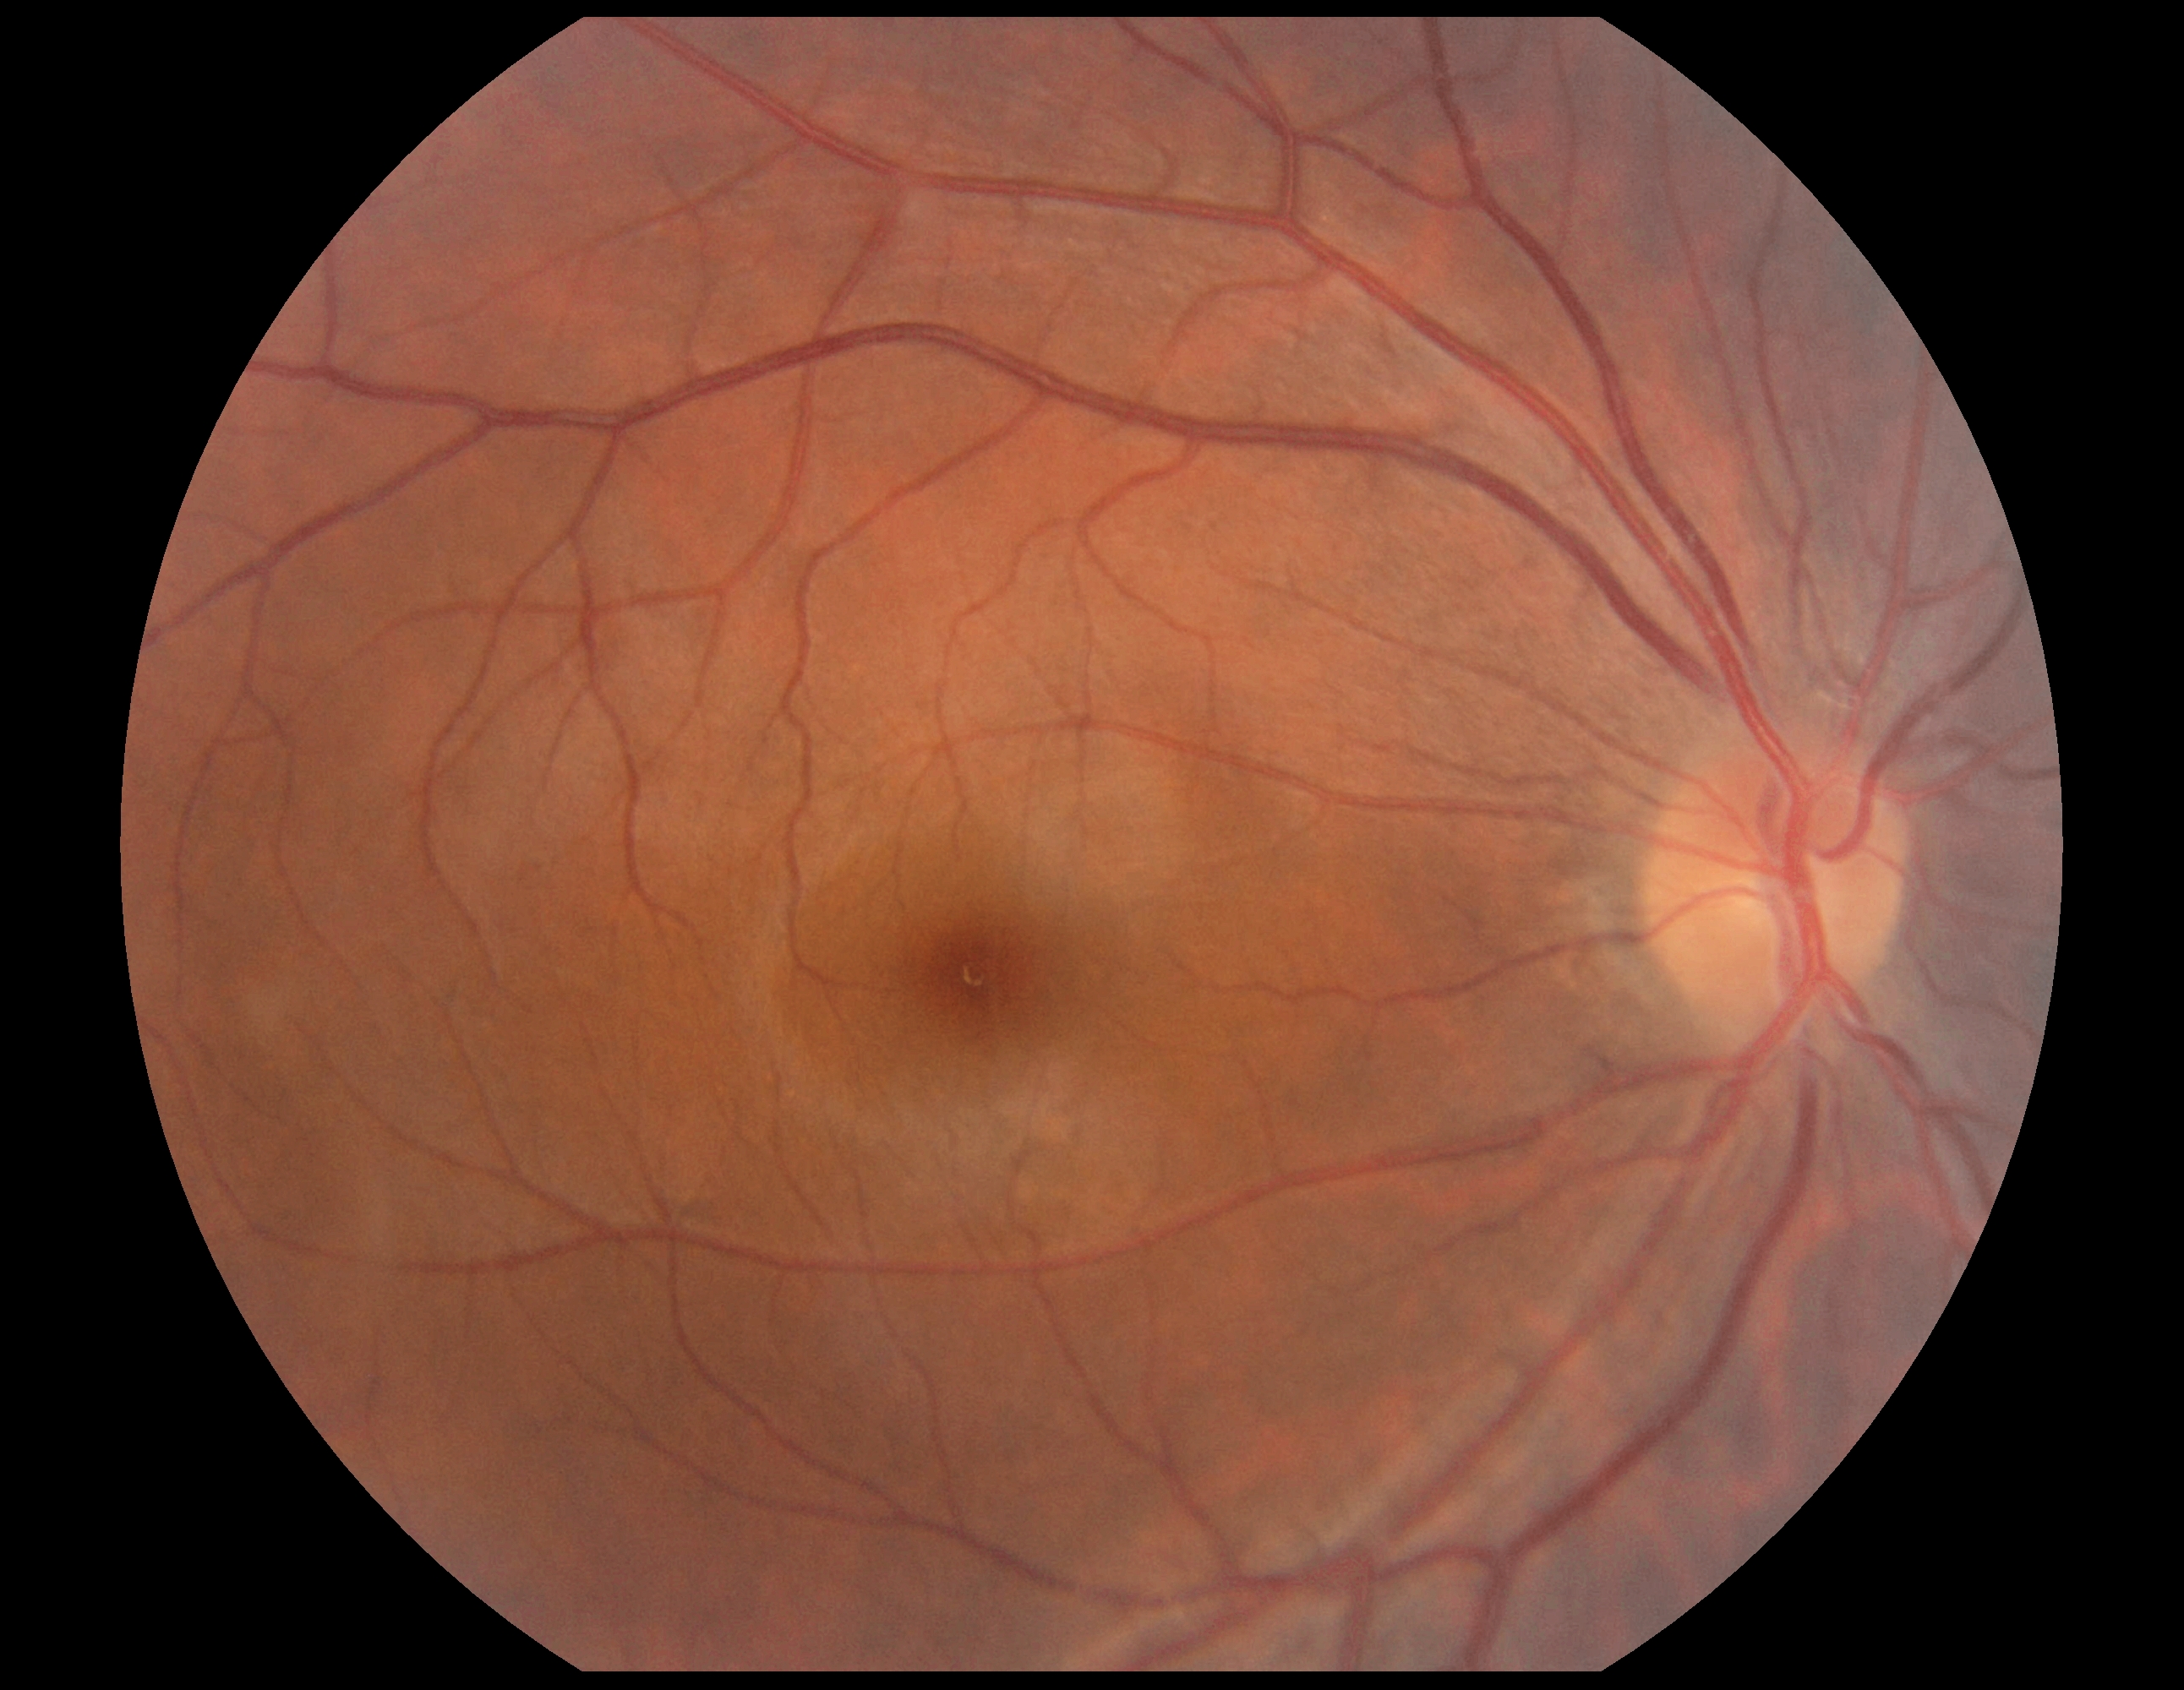

DR is grade 0 (no apparent retinopathy). No signs of diabetic retinopathy.